Fundus photo:
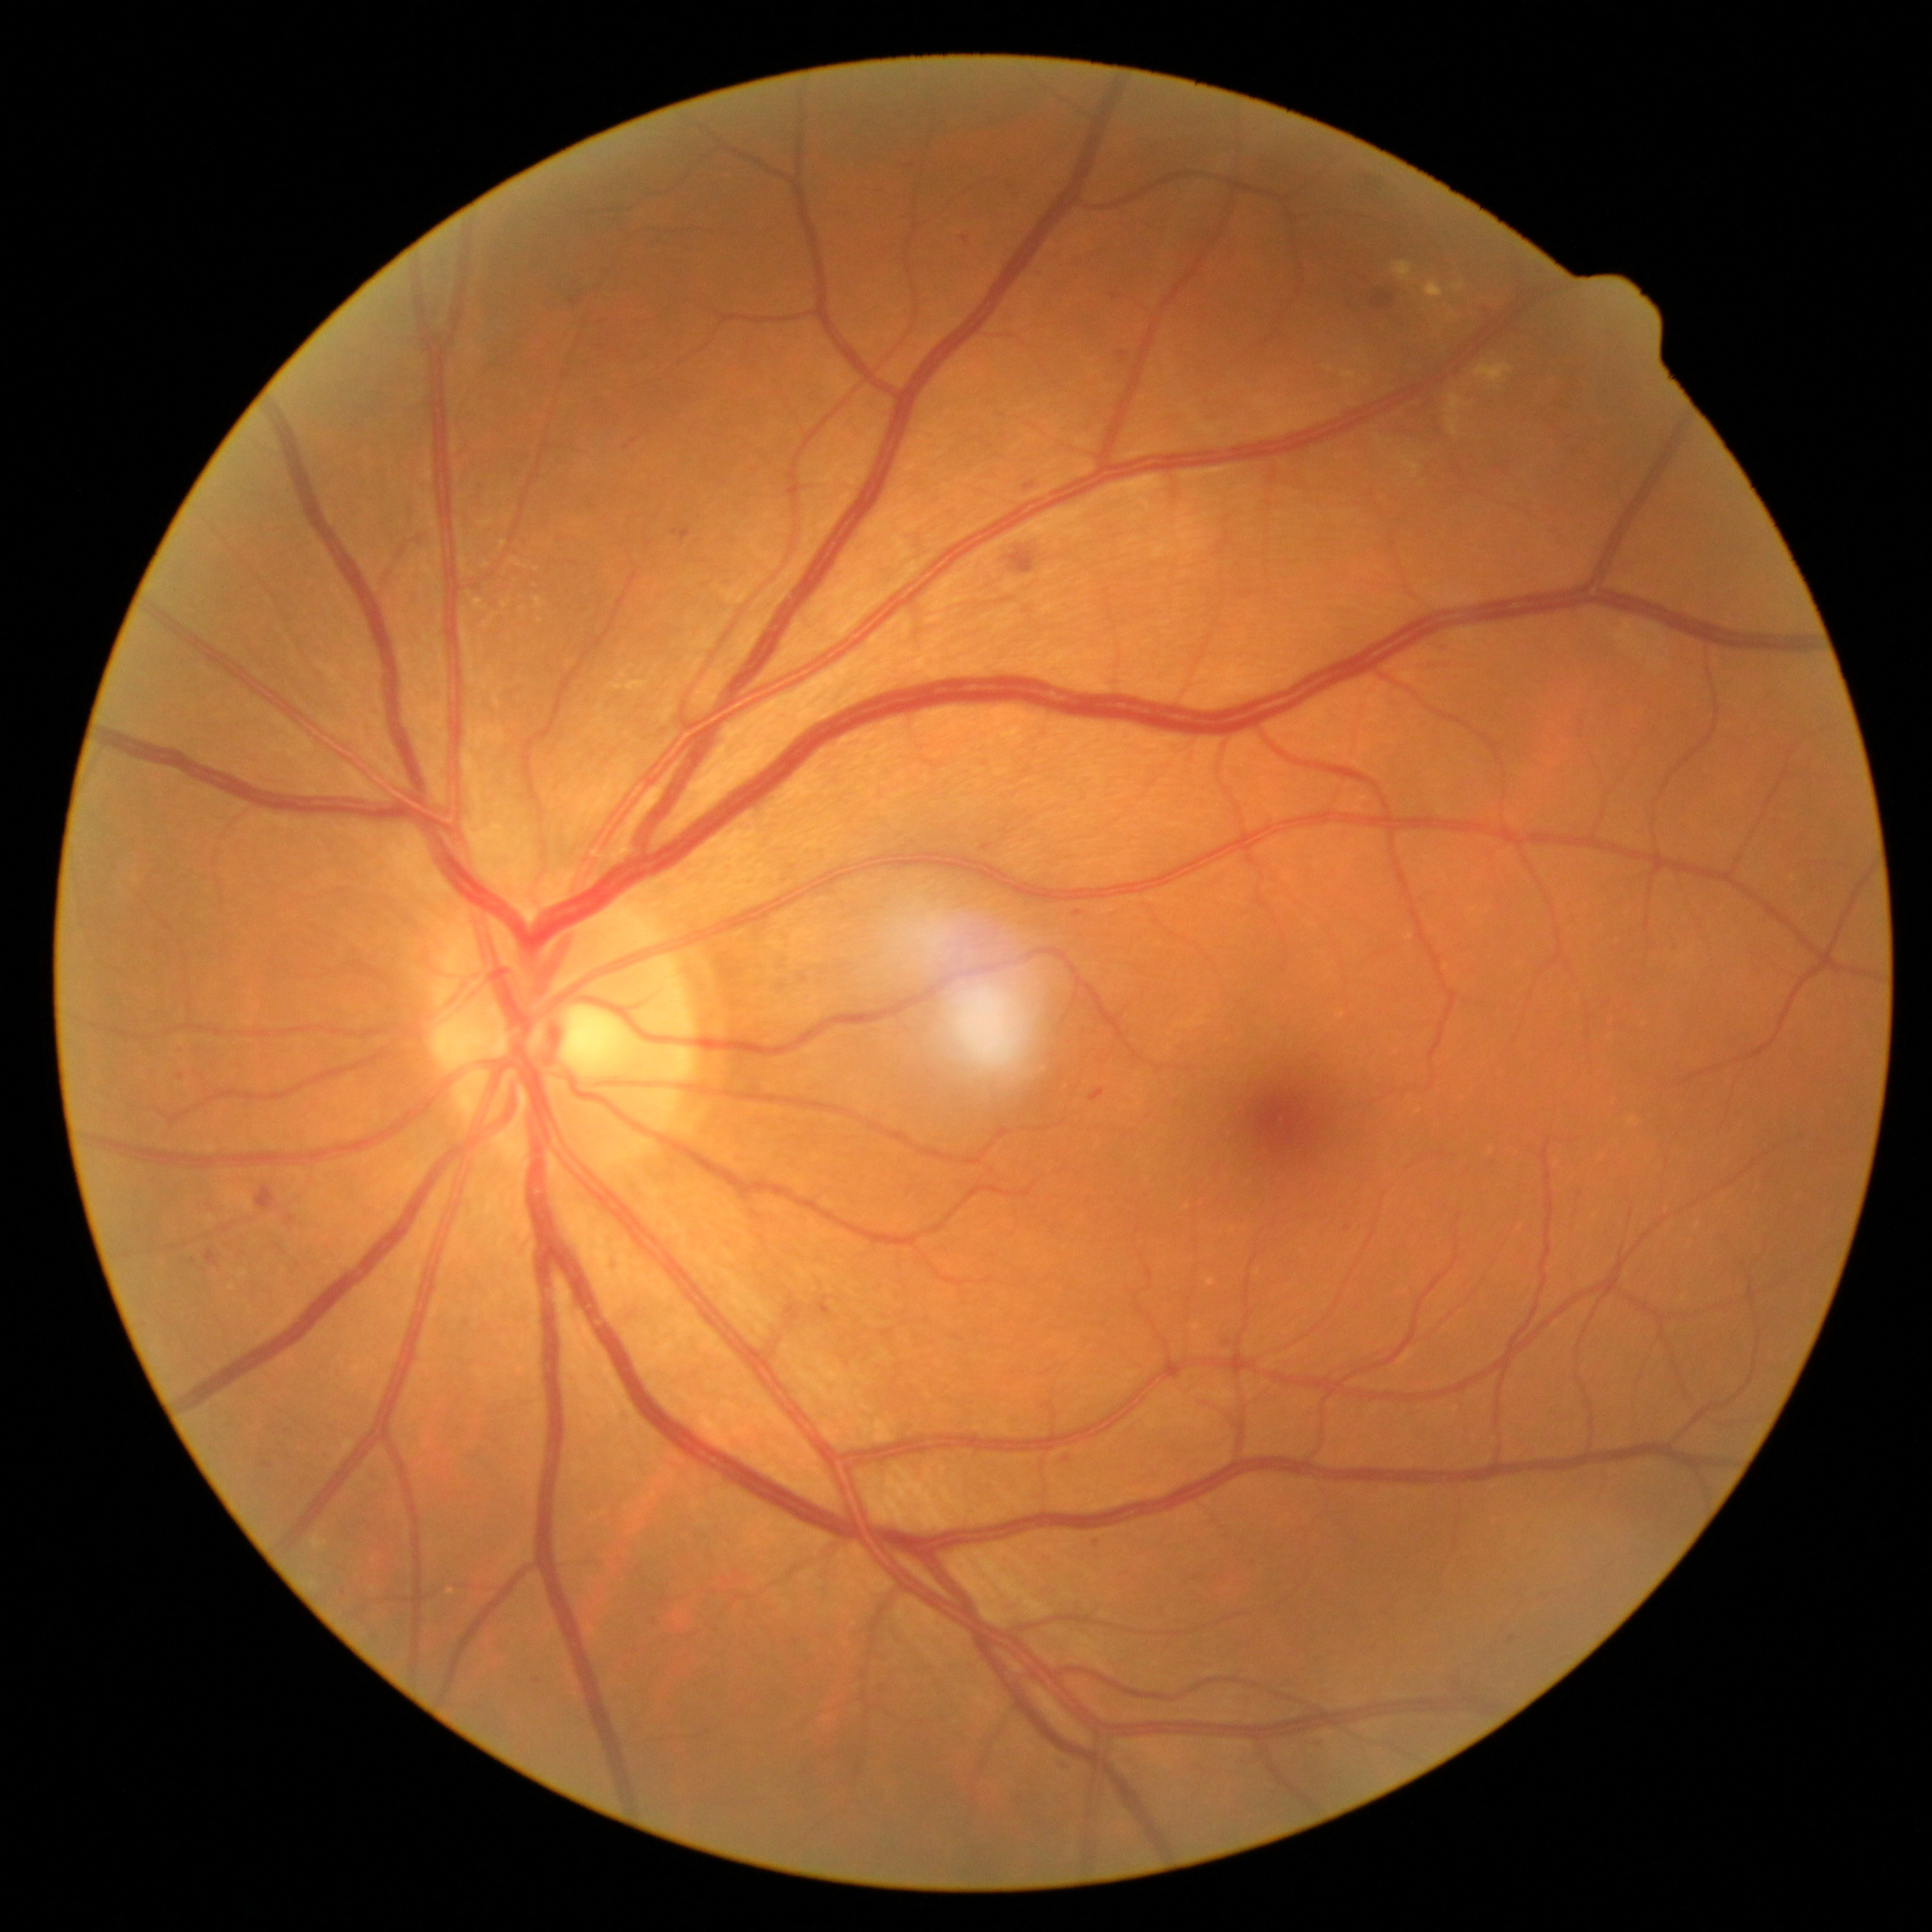
Diabetic retinopathy (DR) is grade 2 — more than just microaneurysms but less than severe NPDR; non-proliferative diabetic retinopathy. Hard exudates (EXs) include lesions at x1=1341 y1=371 x2=1358 y2=380 | x1=1323 y1=365 x2=1334 y2=373 | x1=1394 y1=263 x2=1412 y2=281 | x1=501 y1=542 x2=507 y2=550 | x1=484 y1=622 x2=490 y2=630 | x1=1423 y1=282 x2=1444 y2=299 | x1=510 y1=557 x2=528 y2=569 | x1=460 y1=556 x2=467 y2=572 | x1=534 y1=598 x2=544 y2=610 | x1=1474 y1=364 x2=1512 y2=391. Small EXs approximately at 494, 617 | 1422, 485 | 1360, 351 | 464, 610 | 1423, 456 | 464, 552.